Fundus photo. Nonmydriatic fundus photograph. 848 x 848 pixels. NIDEK AFC-230
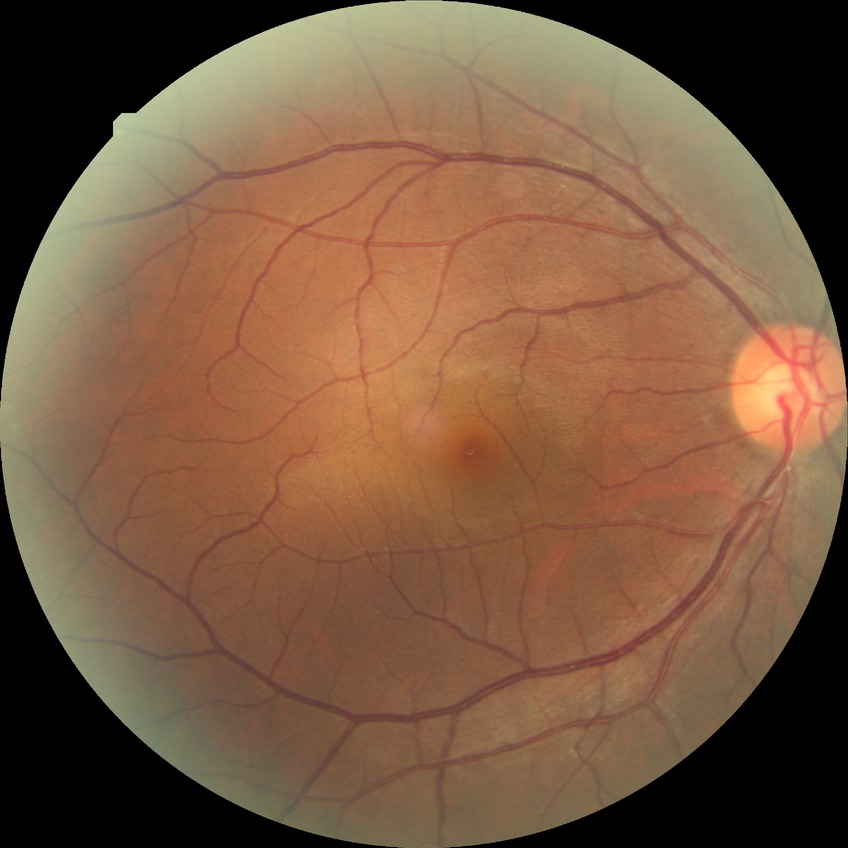 DR: NDR
DR impression: no DR findings